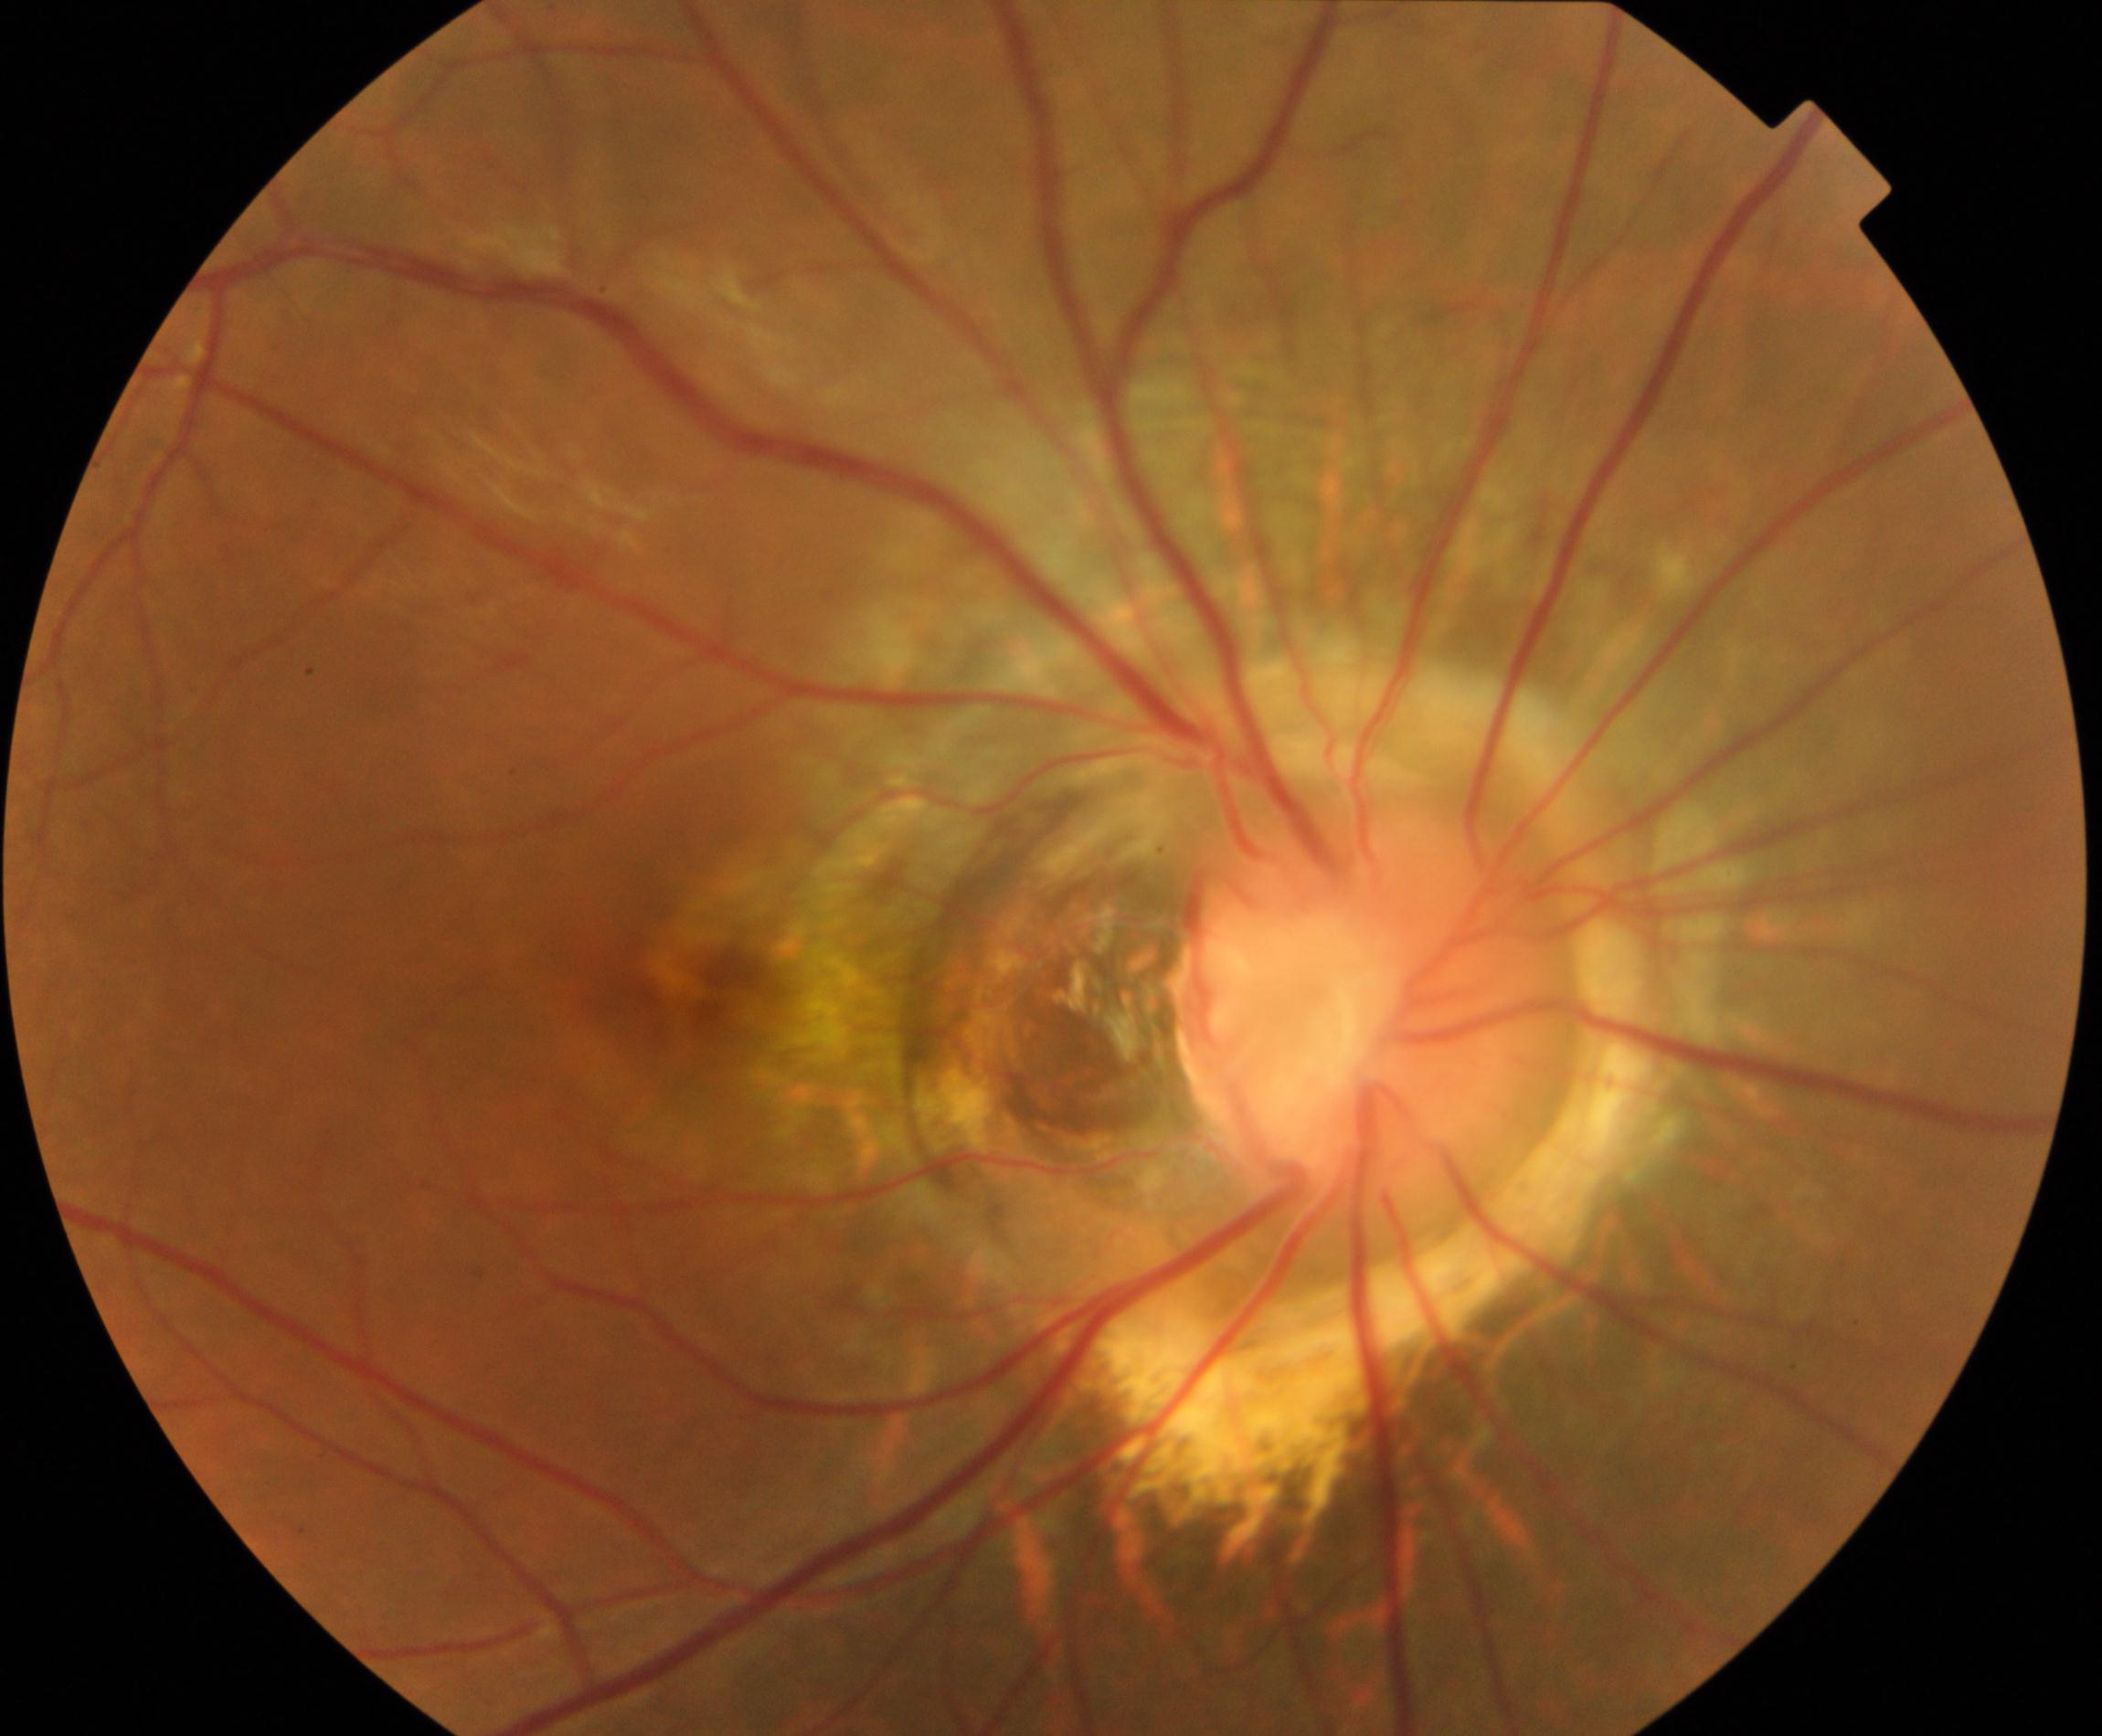

Classification: congenital disc abnormality. Typically showing optic disc coloboma, morning glory anomaly, optic pit, megalopapilla, or hypoplastic disc.